Infant wide-field retinal image:
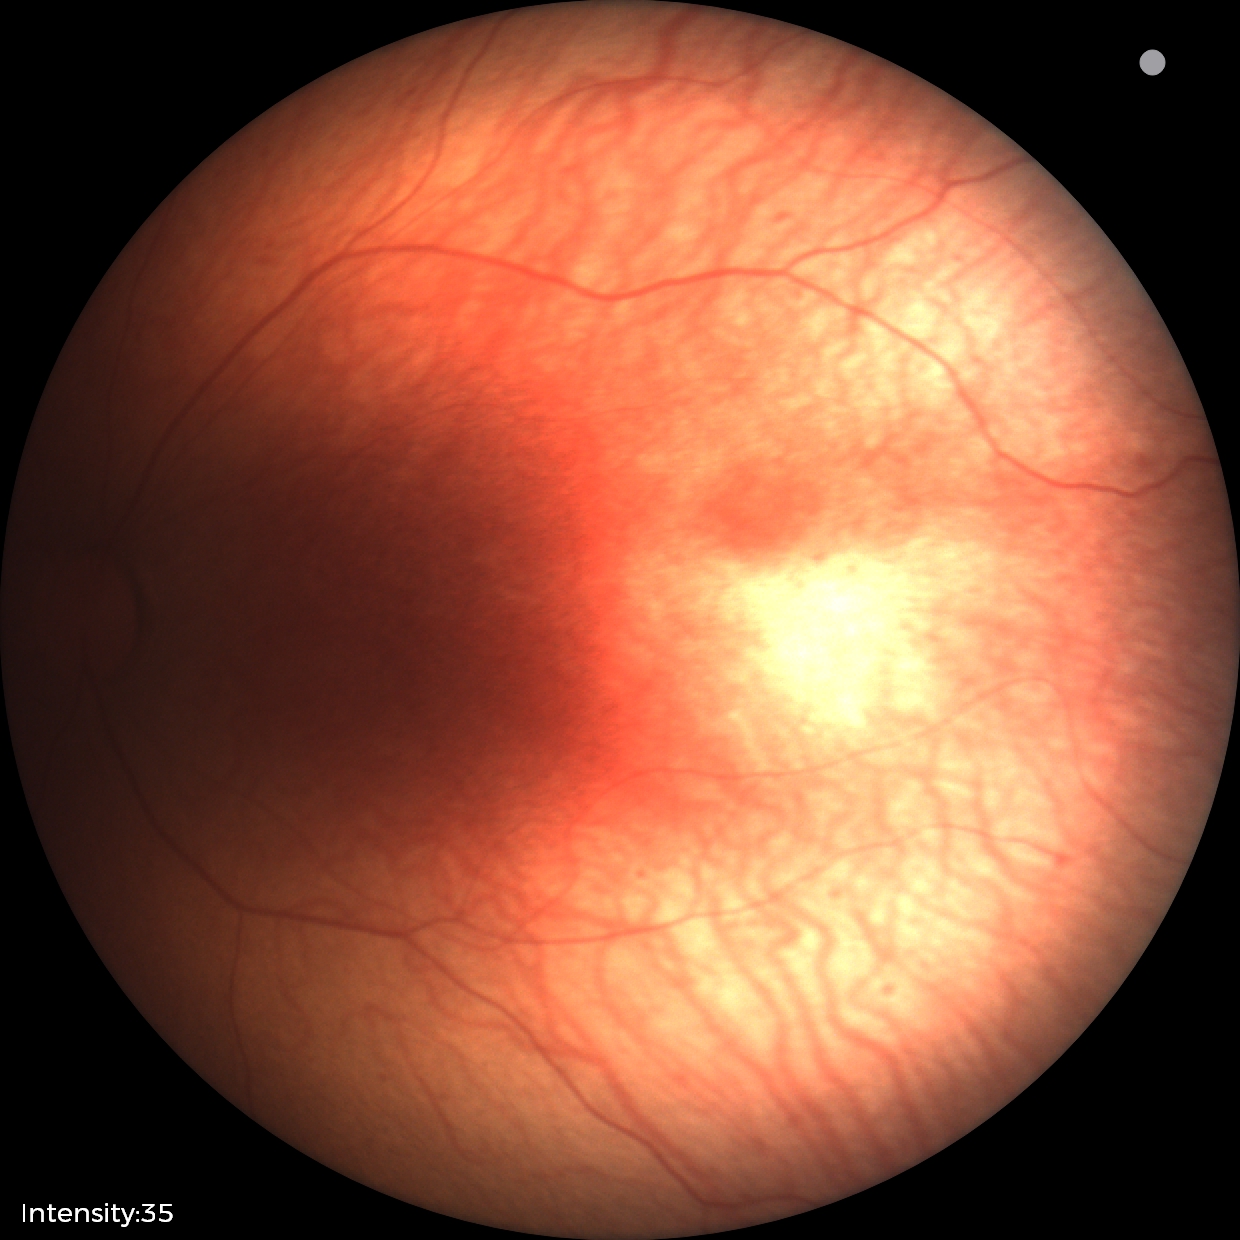
Without plus disease.
Series diagnosed as ROP stage 1.